Intraocular pressure 15 mmHg; 59 years old; central corneal thickness 562 µm: 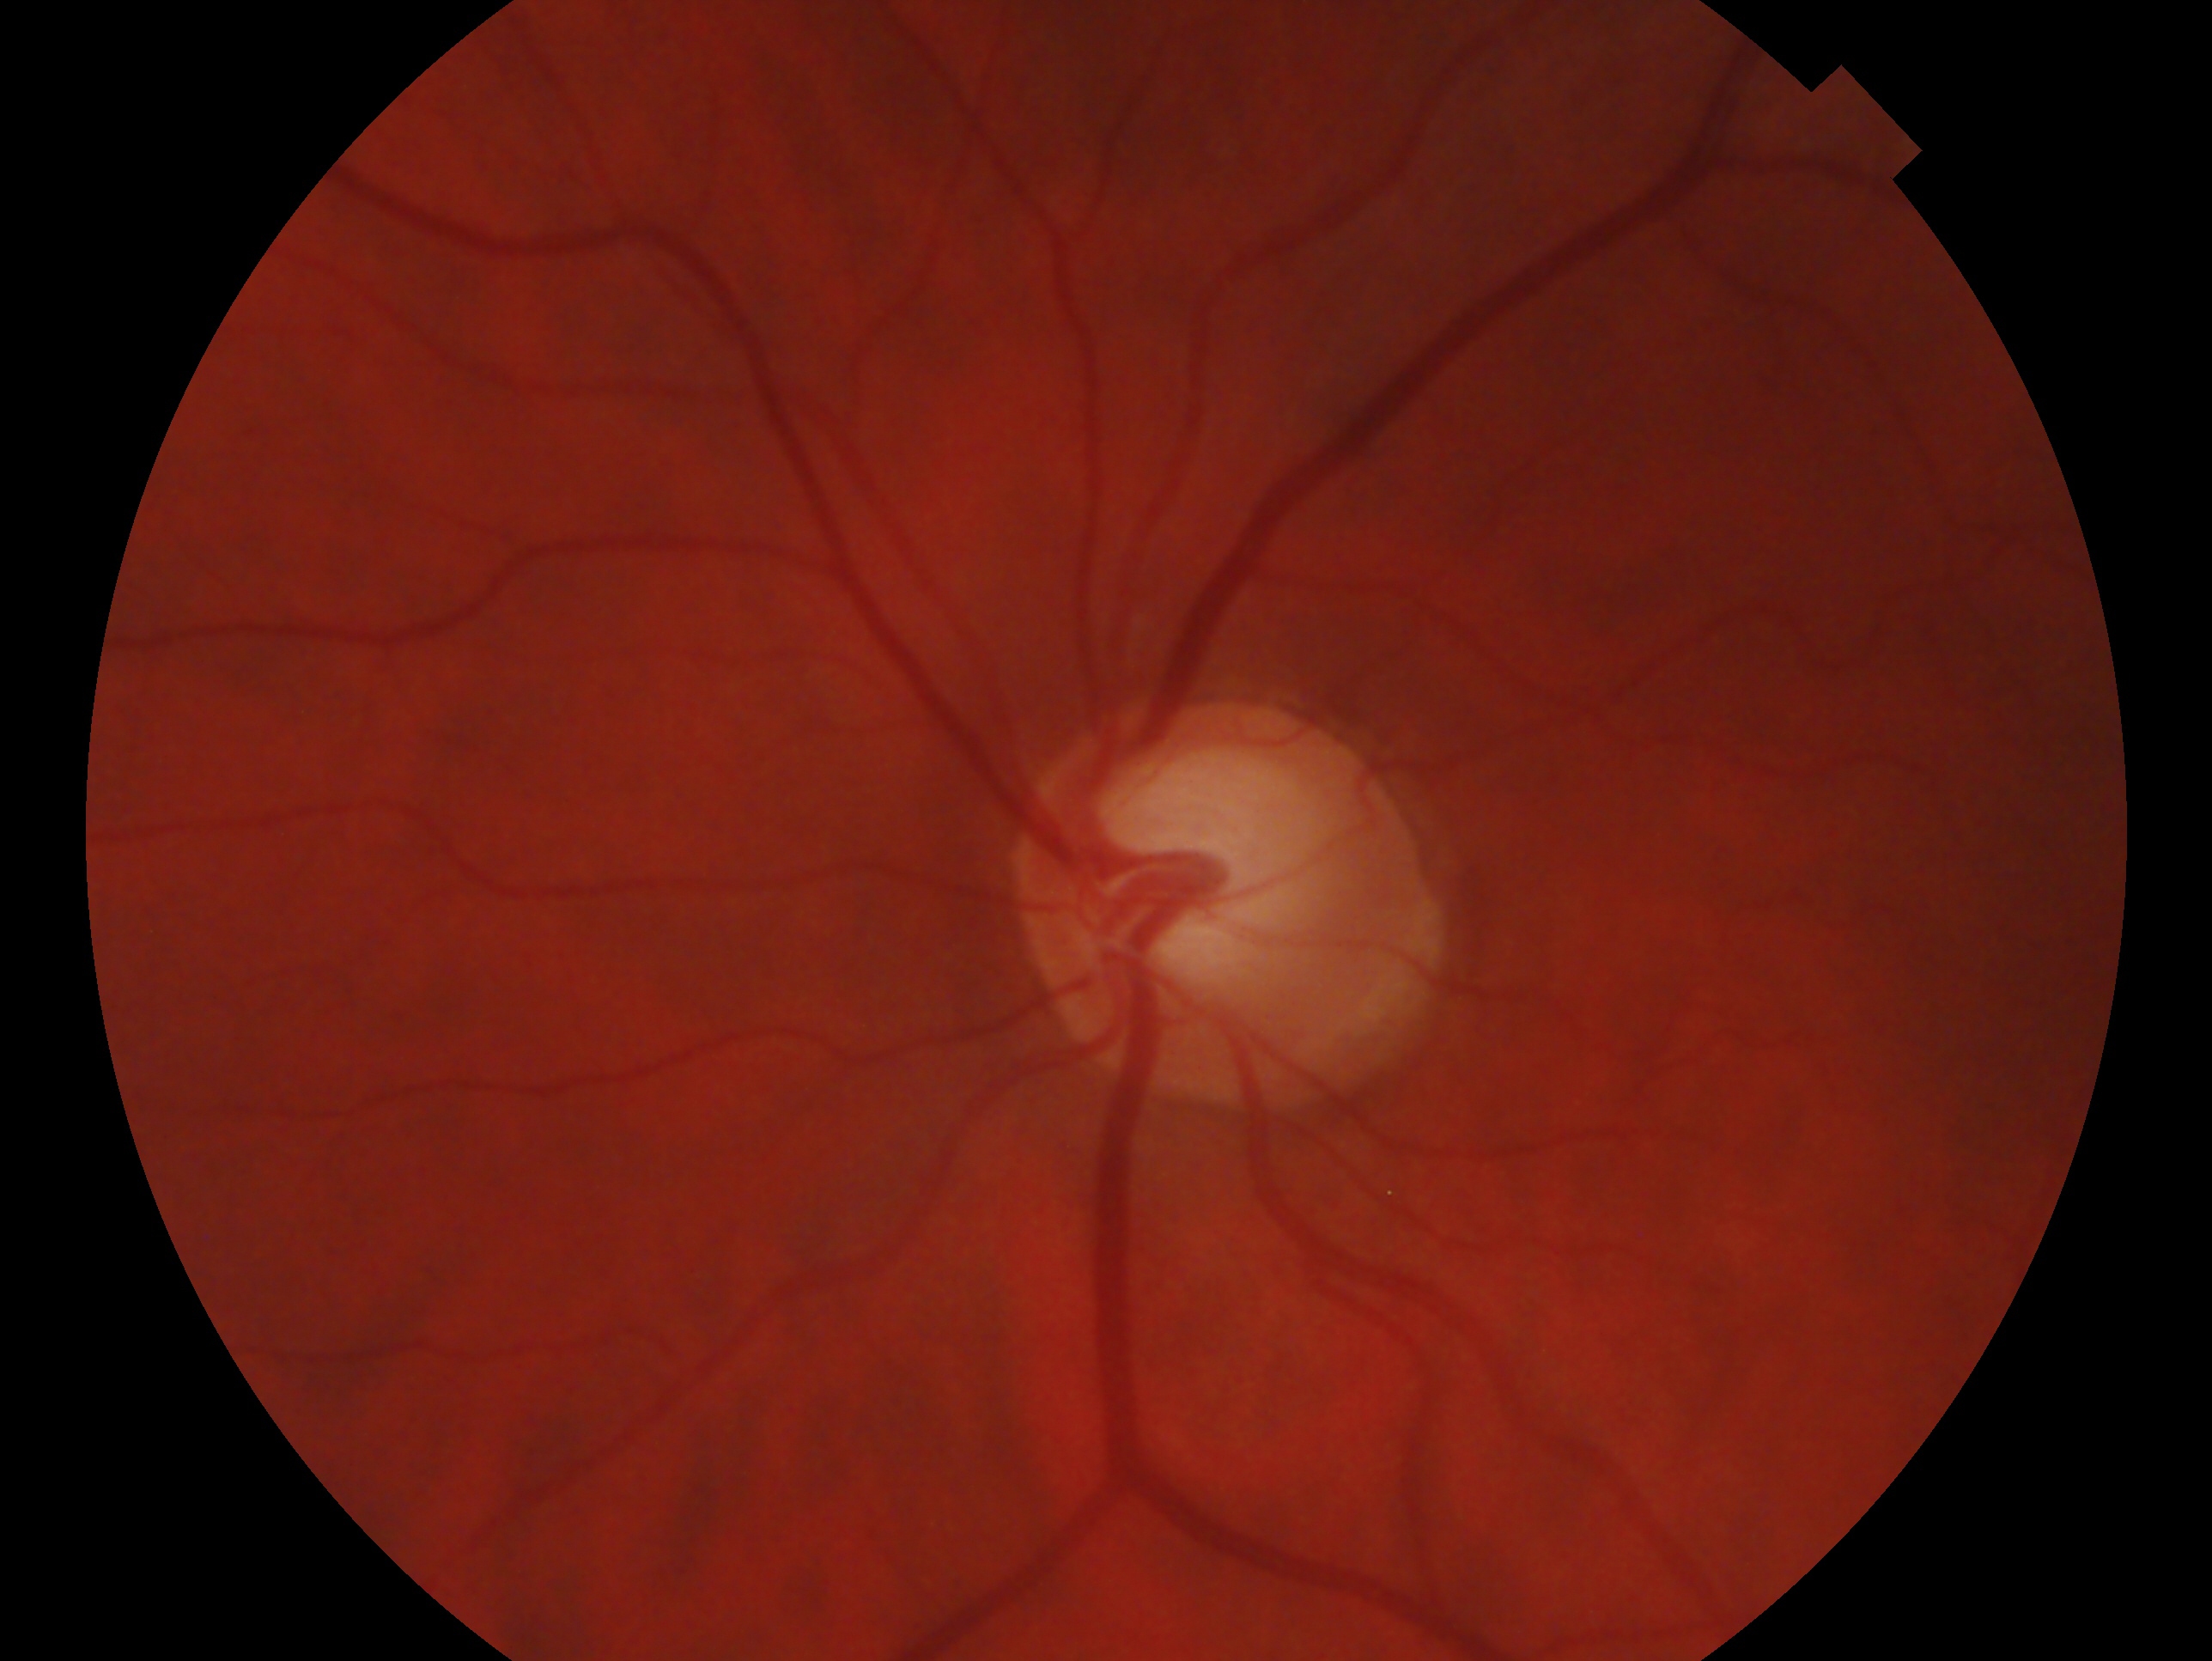 glaucoma status: cannot be excluded
laterality: left